2212 x 1659 pixels · CFP.
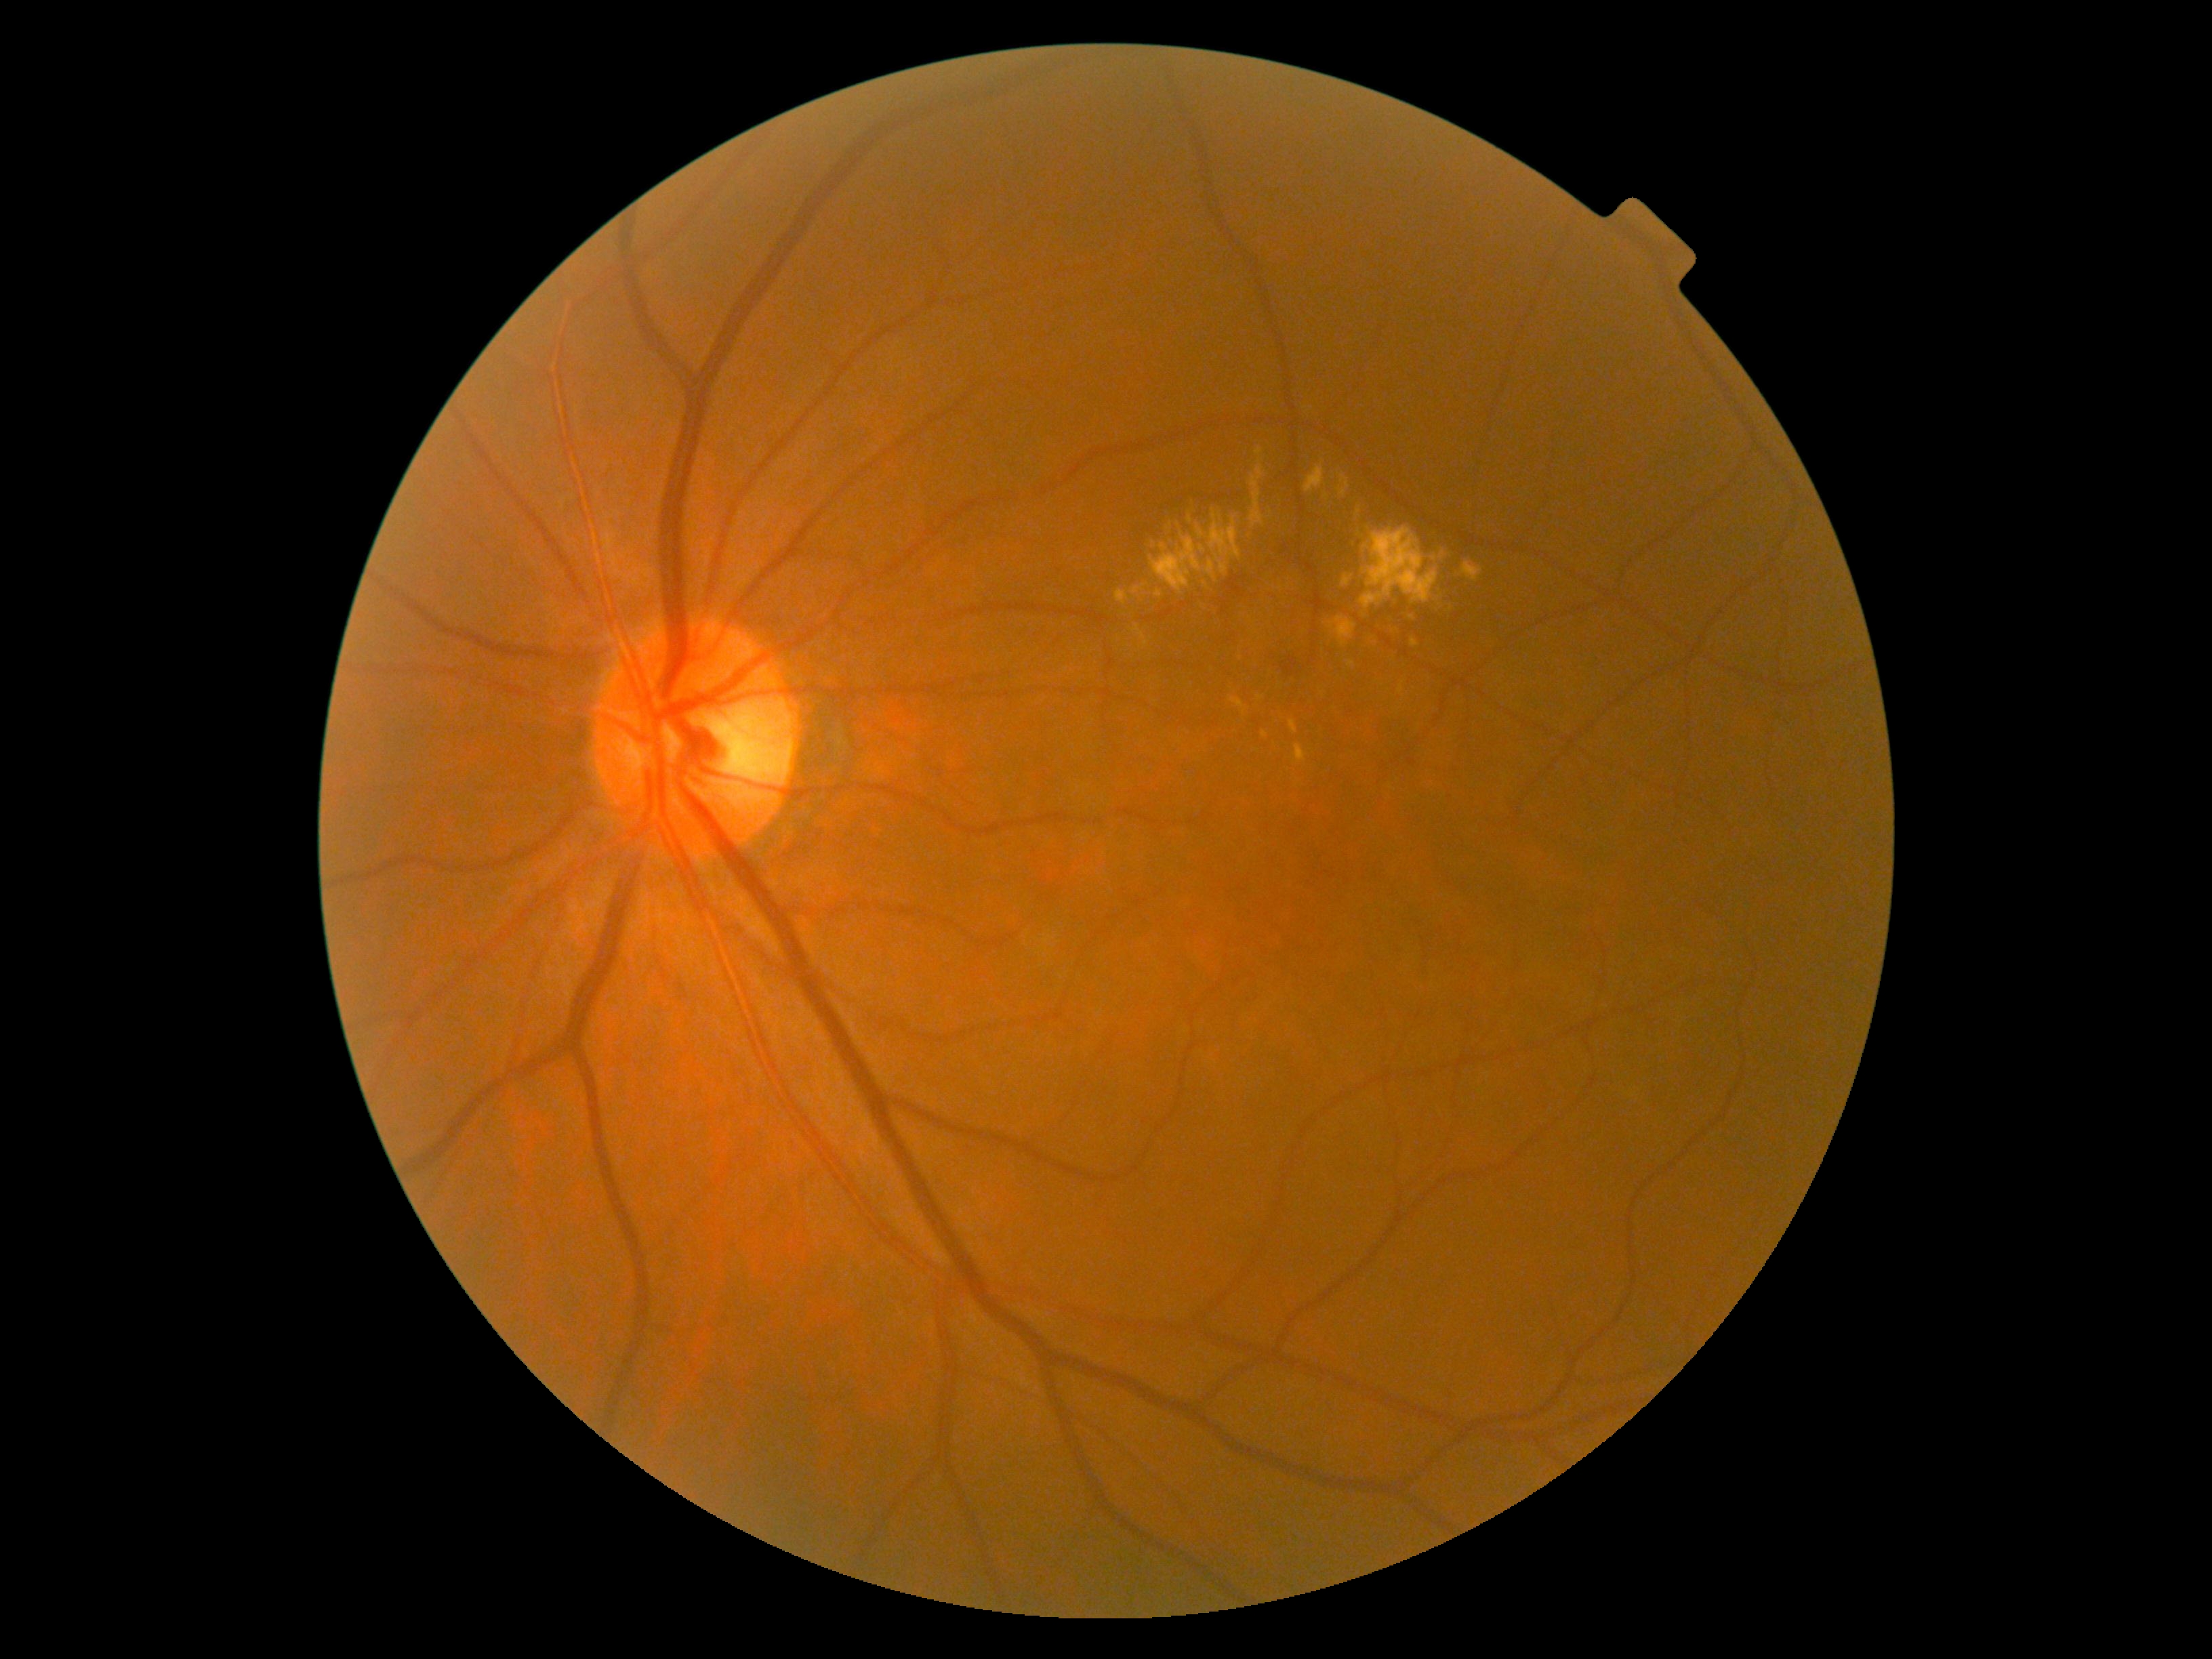 DR class = non-proliferative diabetic retinopathy
diabetic retinopathy (DR) = 2/4